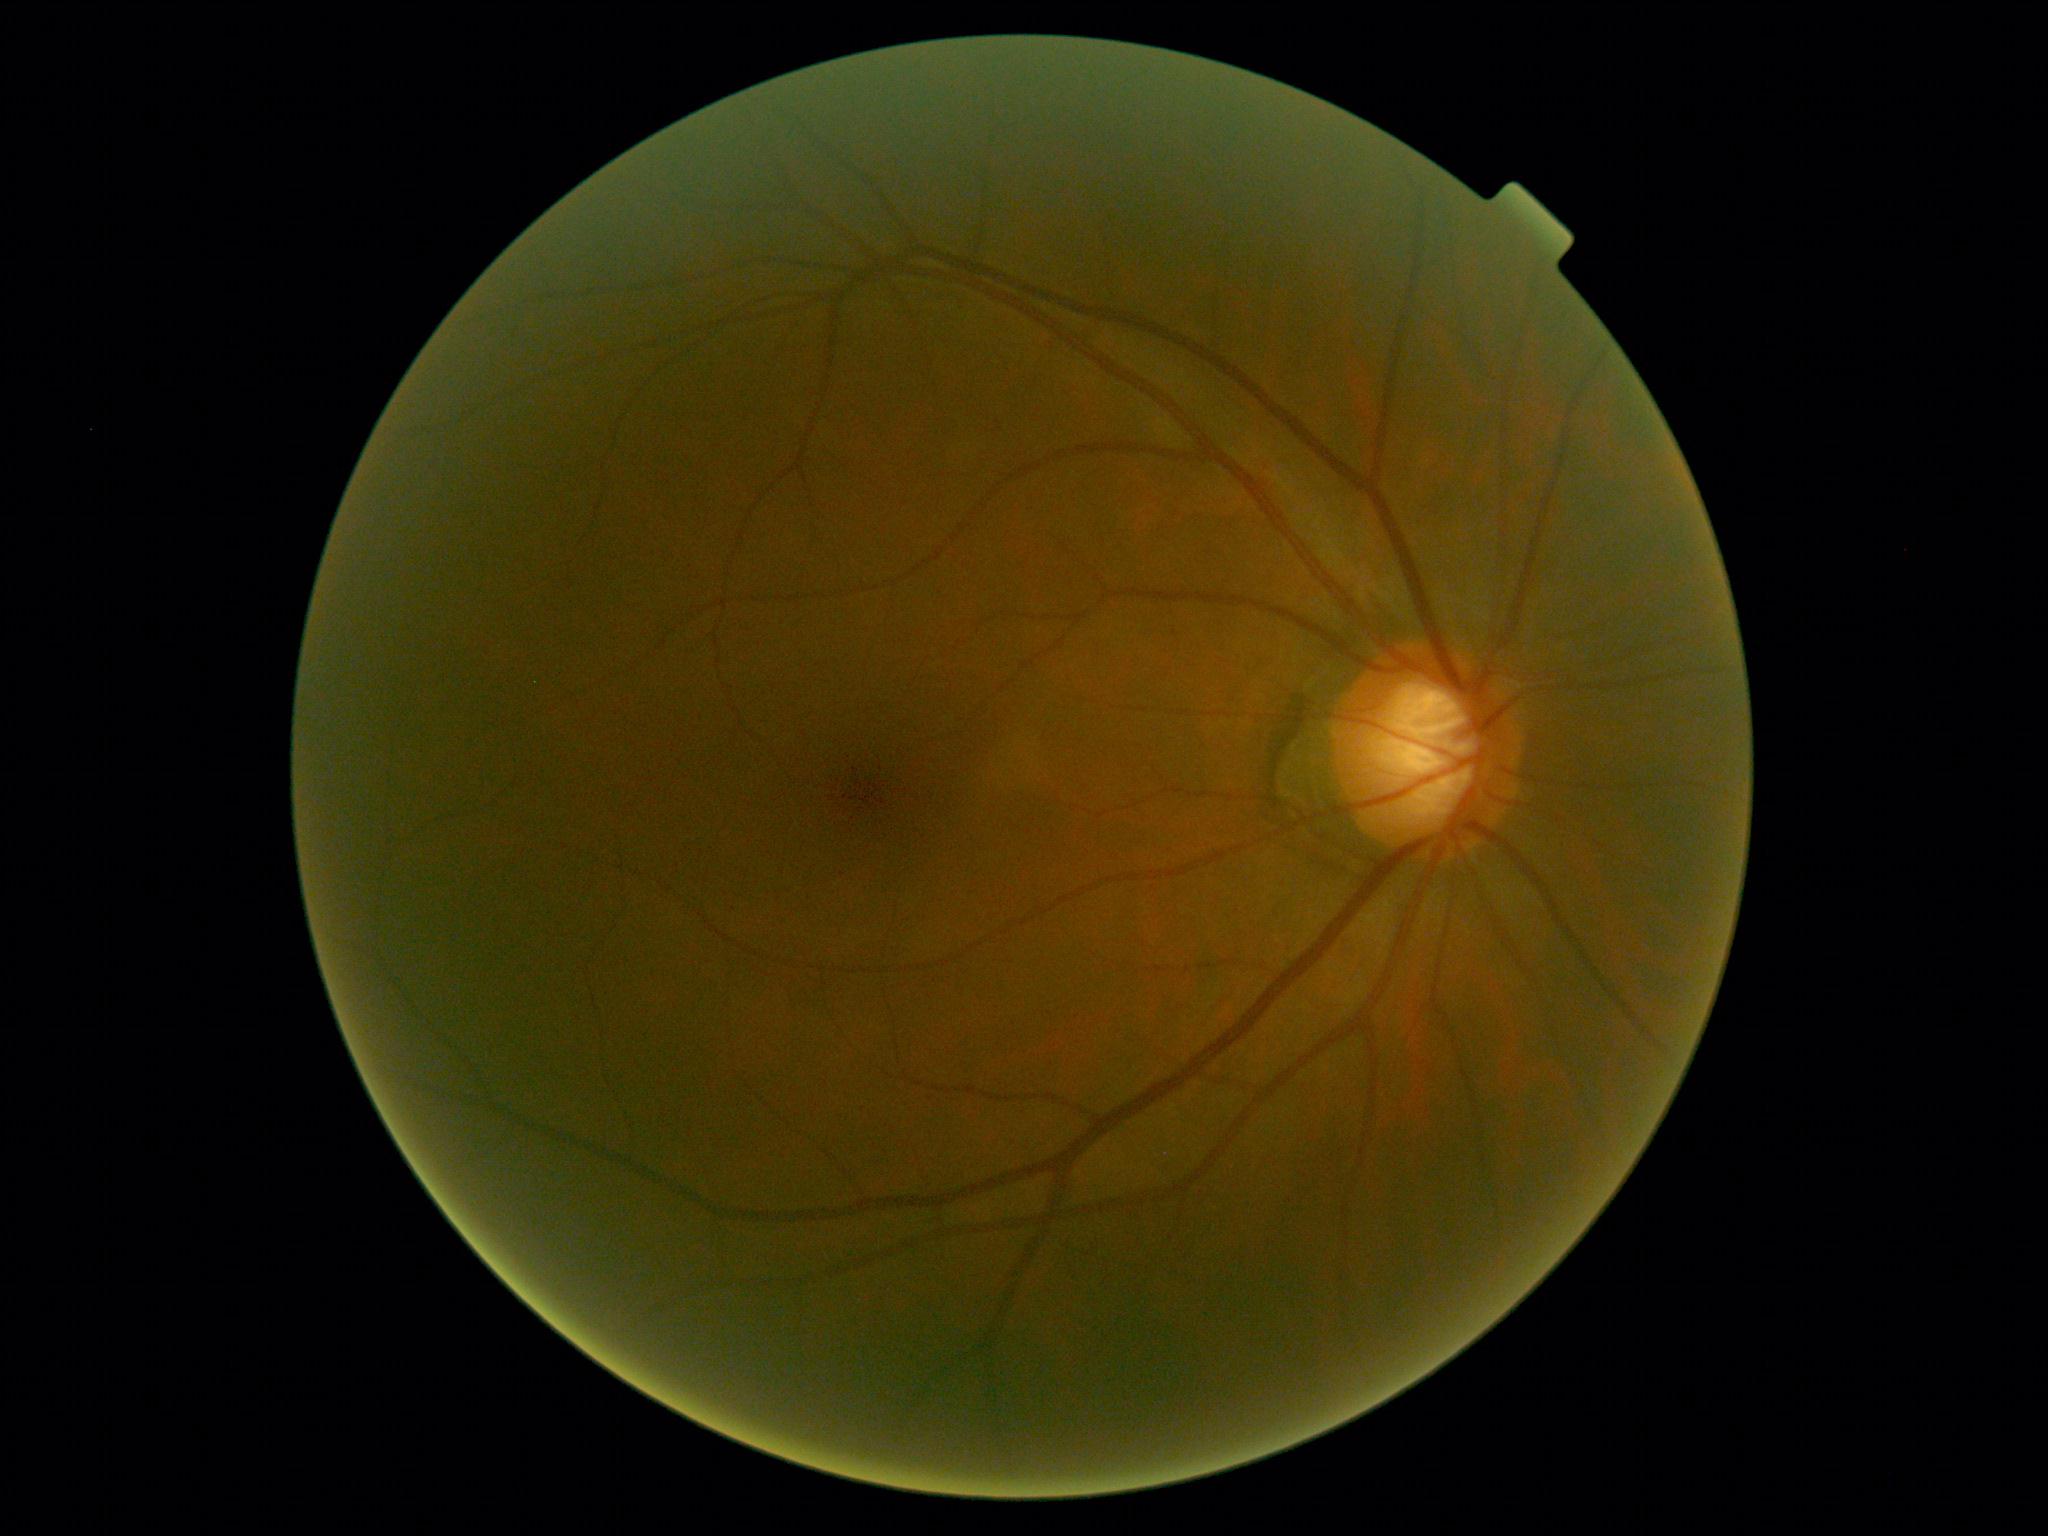 diabetic retinopathy severity: no apparent diabetic retinopathy (grade 0).